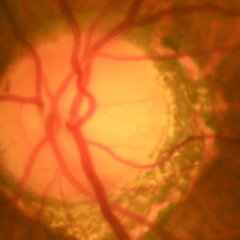
Optic disc photograph demonstrating no glaucoma.